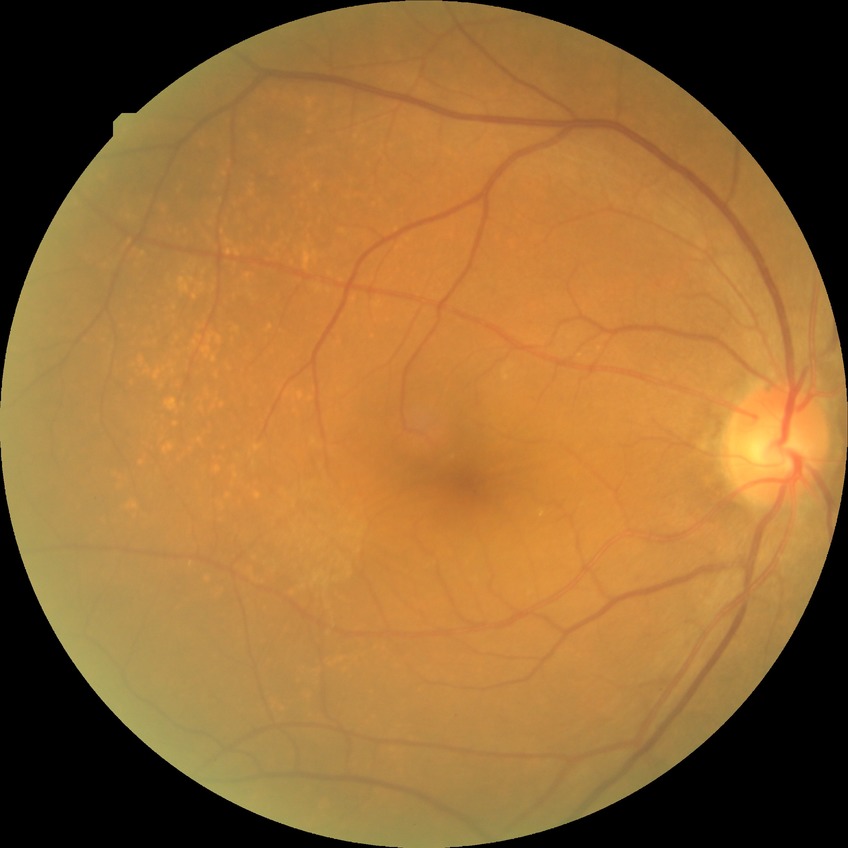 diabetic retinopathy (DR): NDR (no diabetic retinopathy)